FOV: 45 degrees. 2212 x 1659 pixels. Retinal fundus photograph — 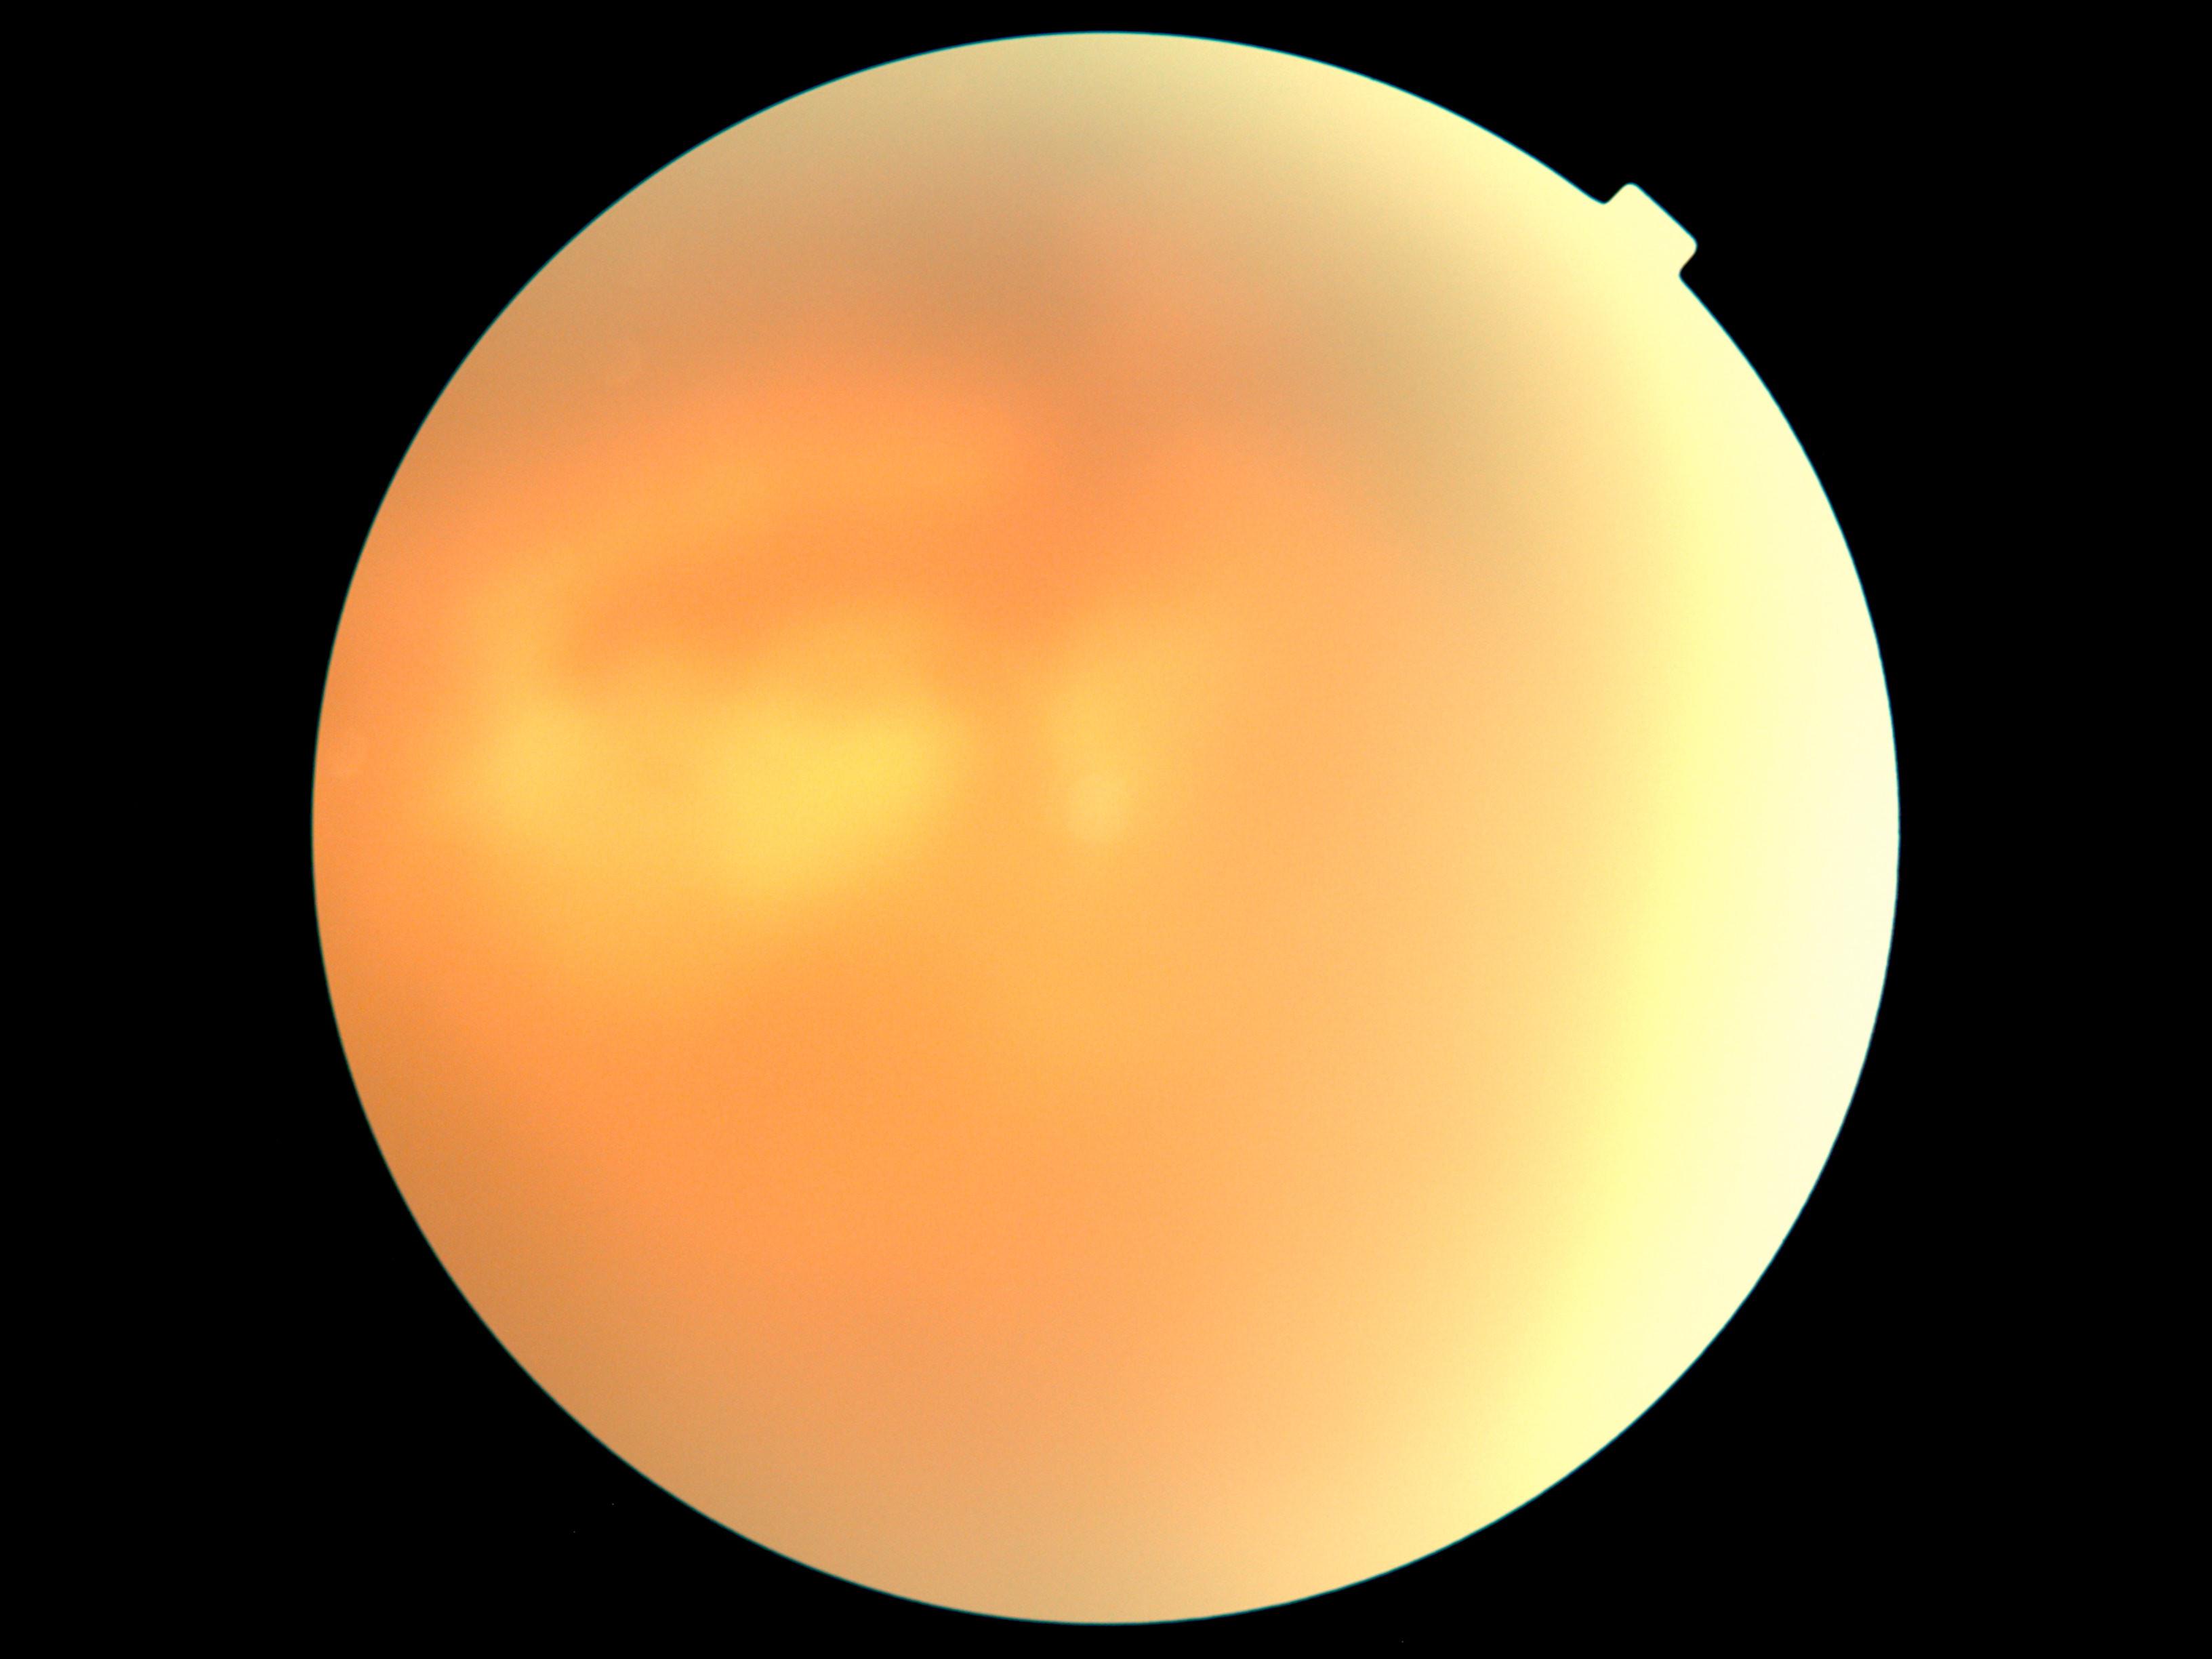
Diabetic retinopathy grade is ungradable due to poor image quality.